CFP.
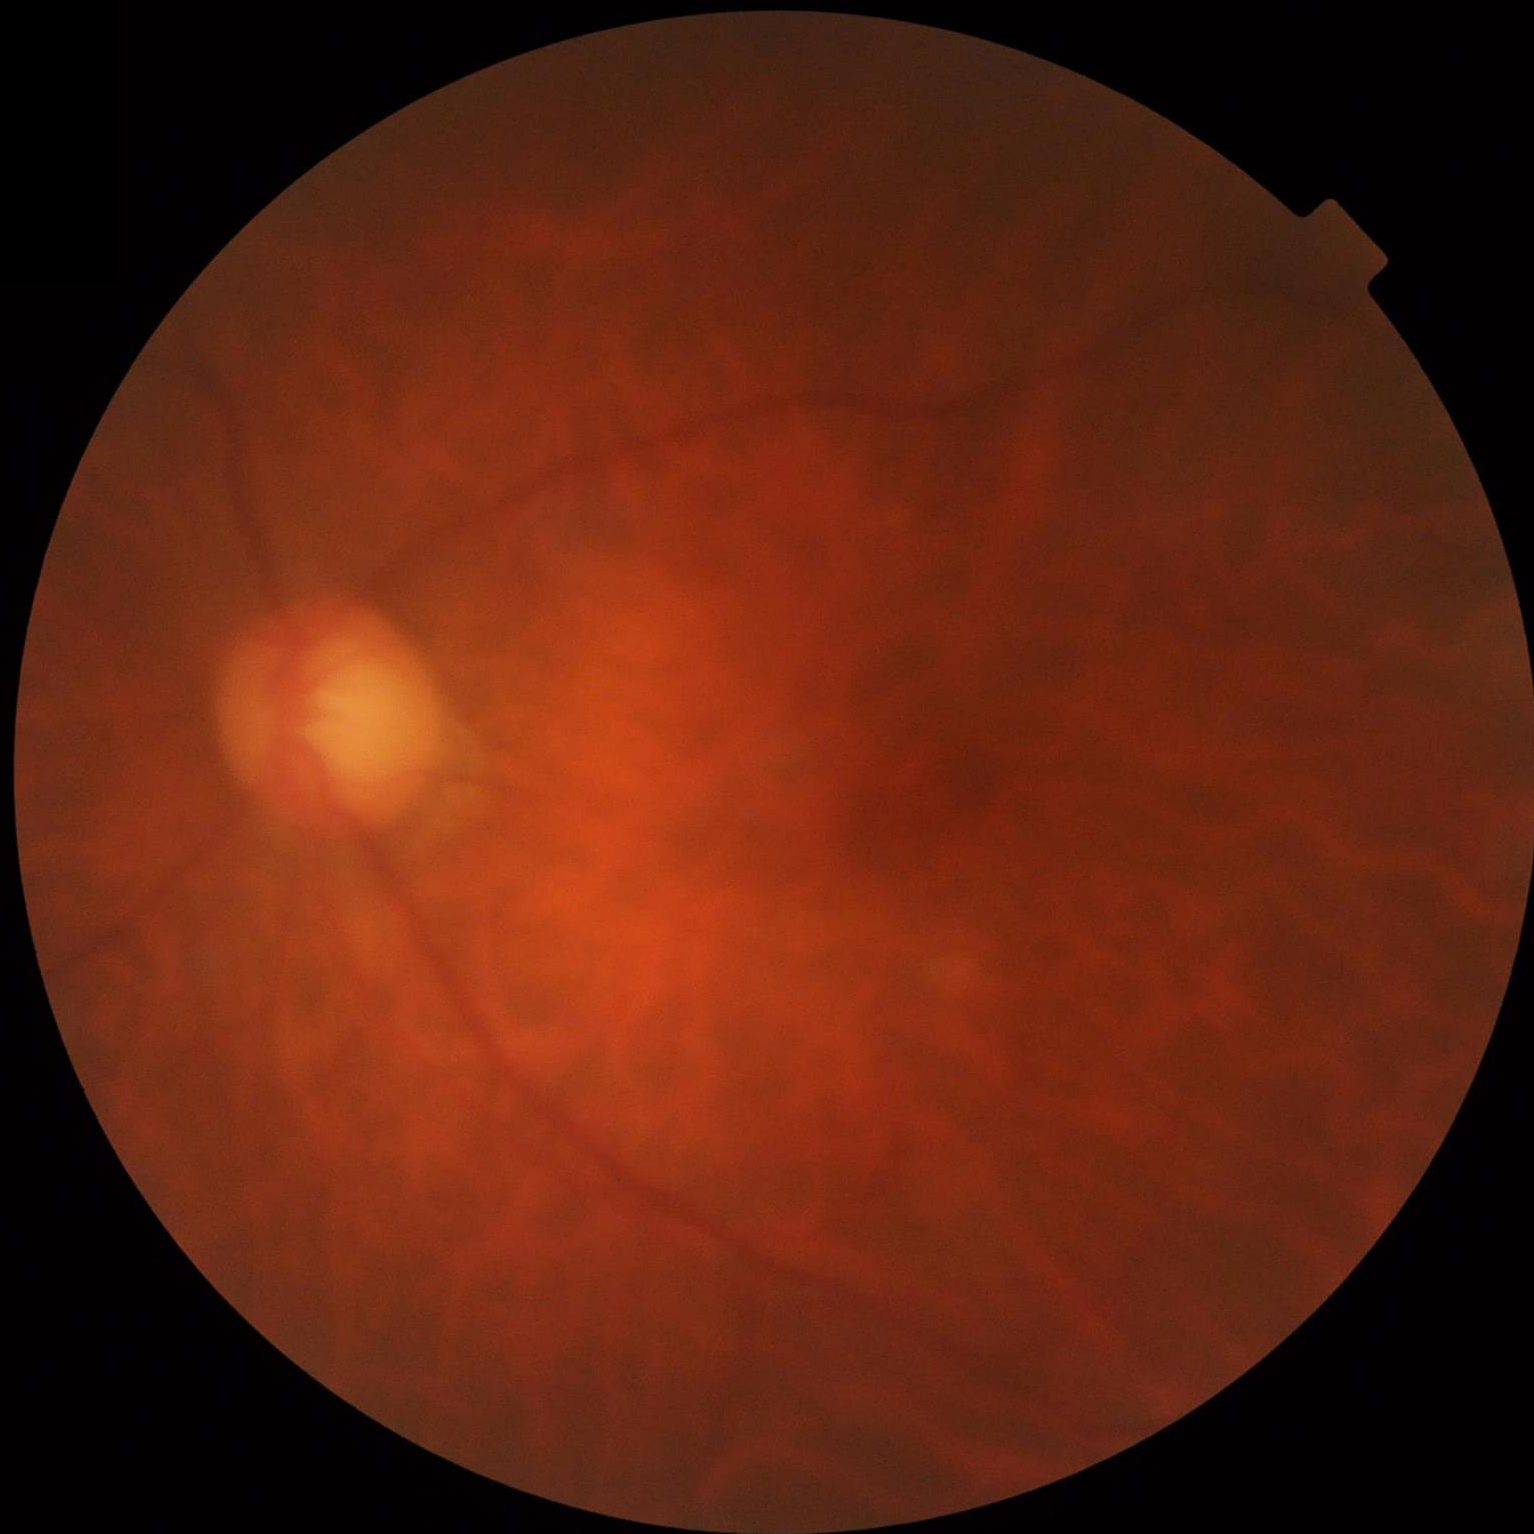
Out of focus; structures are indistinct.
Illumination is even.
Overall image quality is poor.
Poor dynamic range.